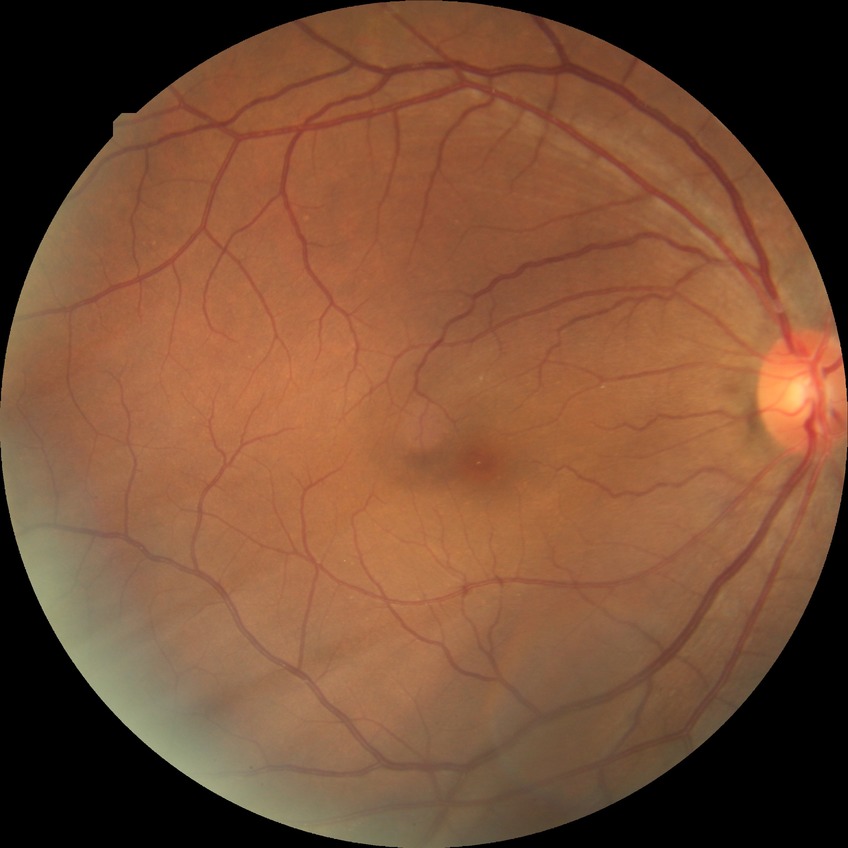

Diabetic retinopathy stage is no diabetic retinopathy.